Color fundus photograph.
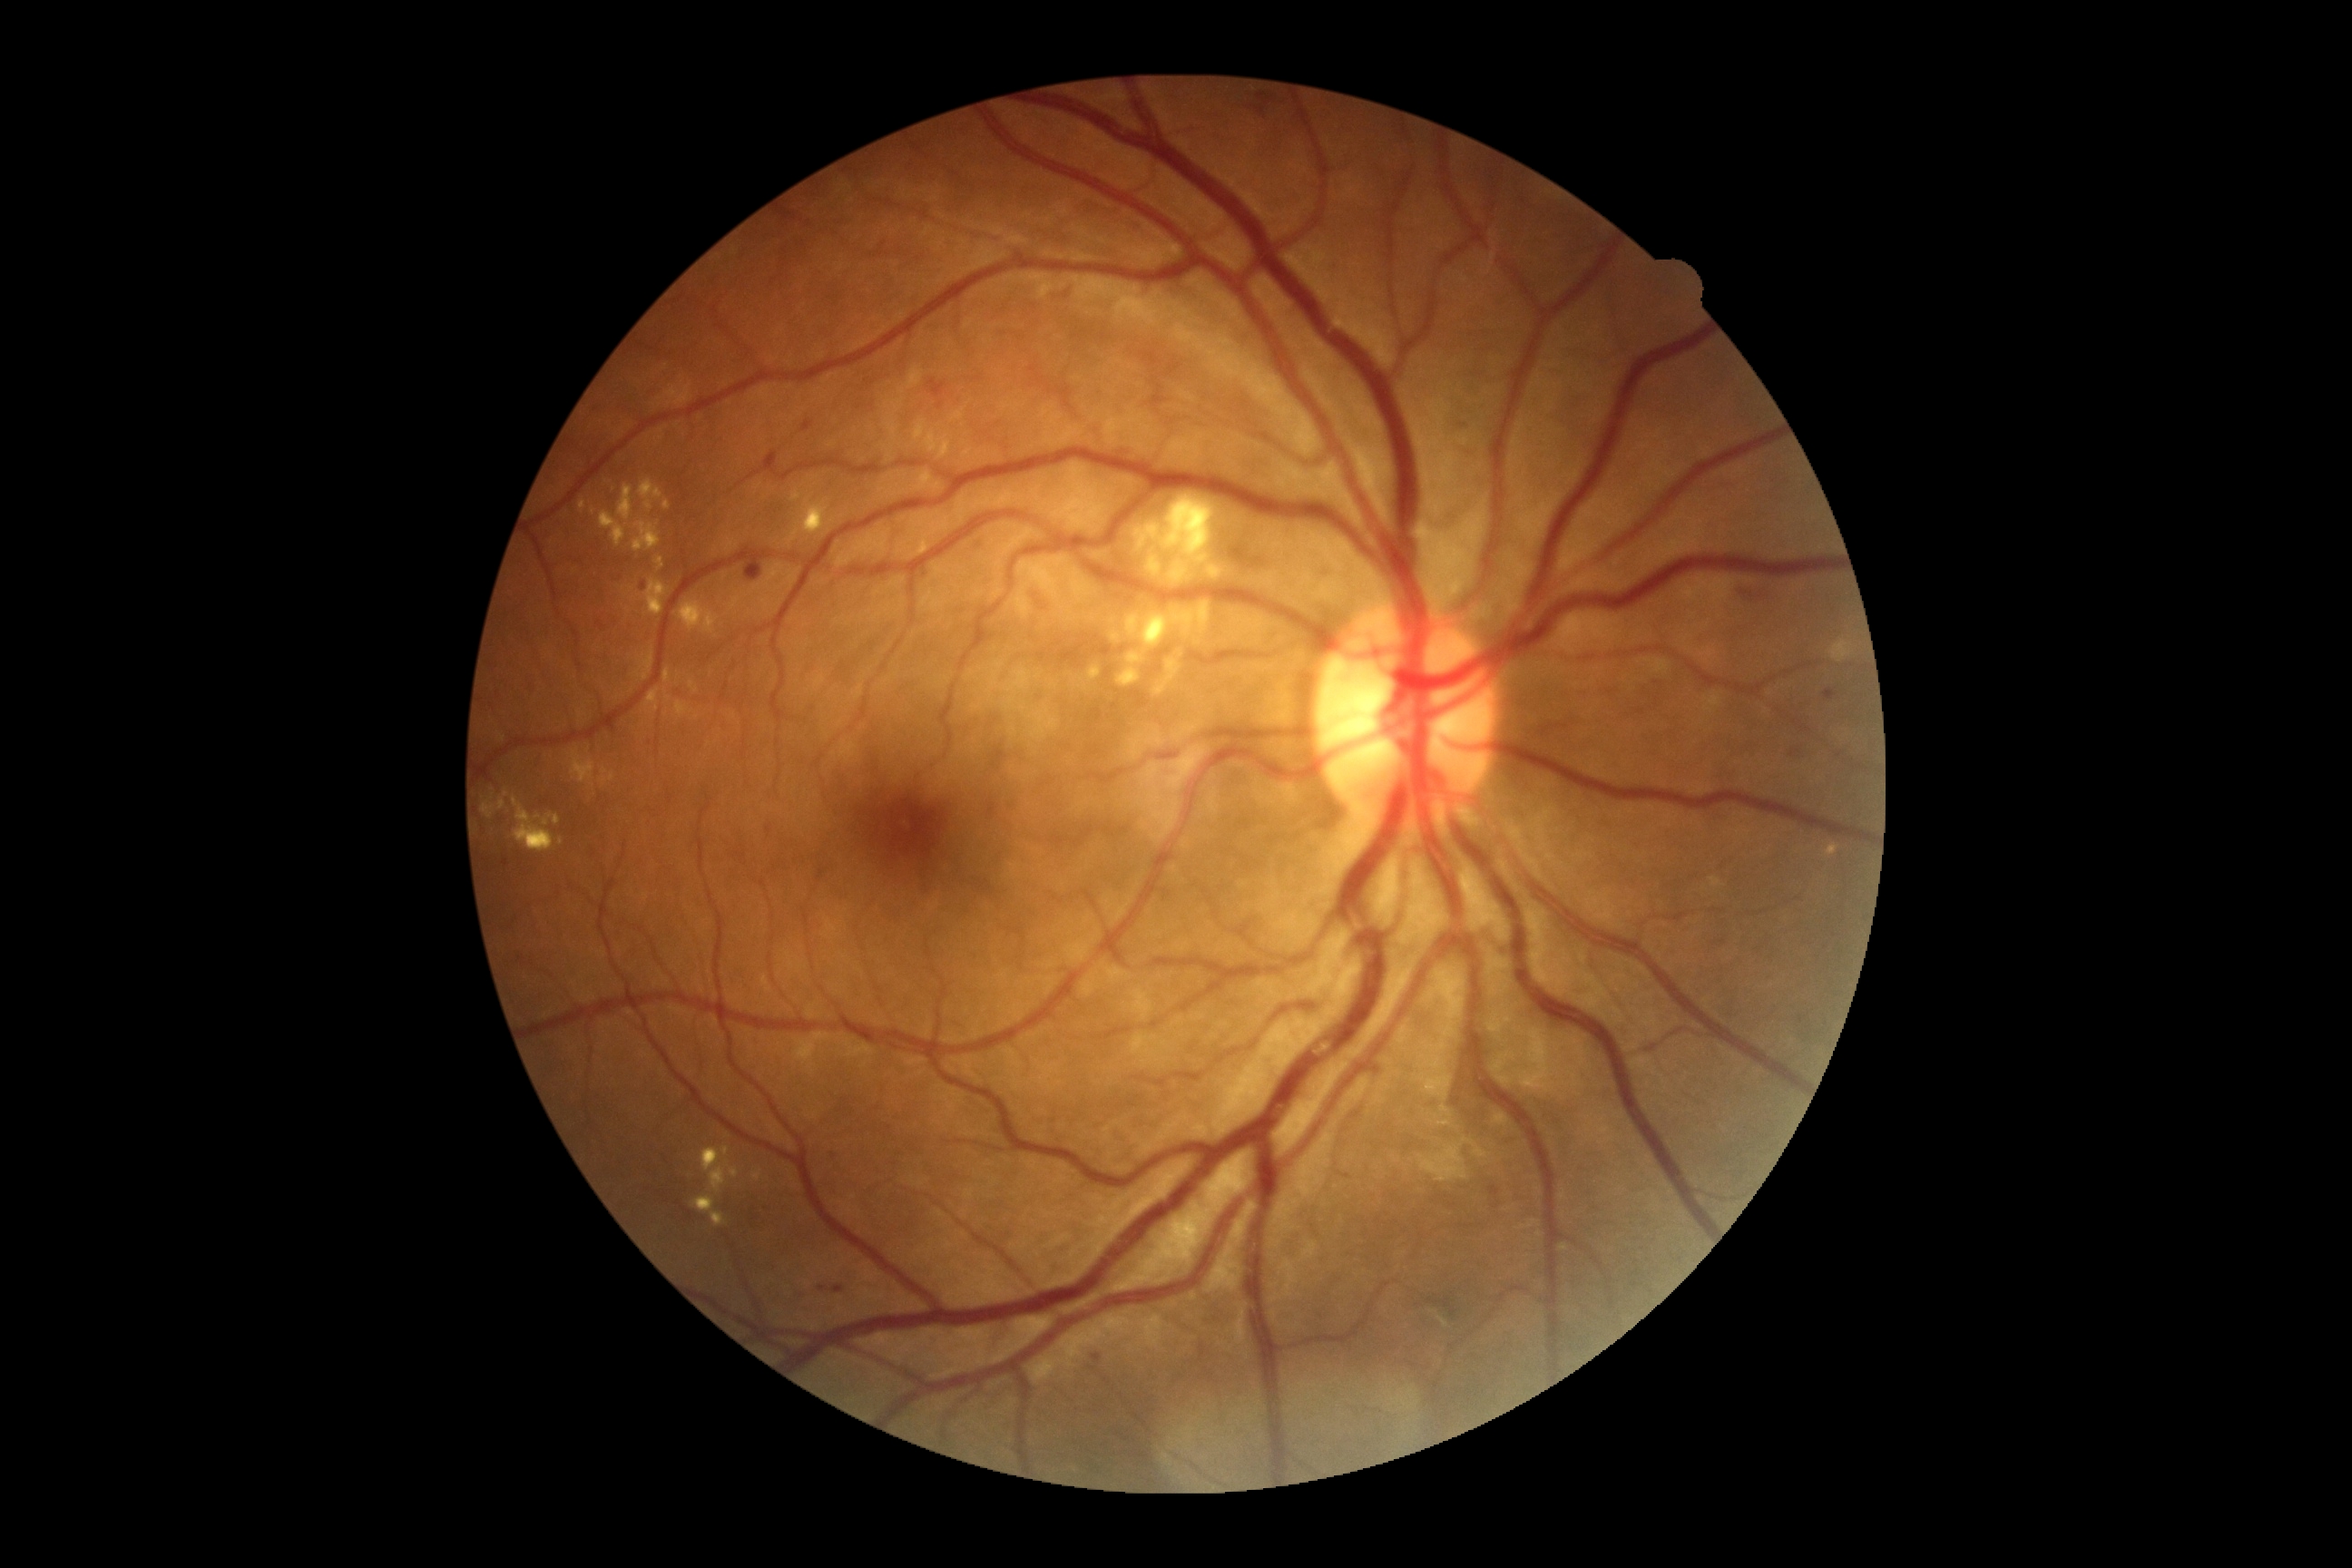 diabetic retinopathy severity@moderate non-proliferative diabetic retinopathy (grade 2).